Wide-field fundus photograph from neonatal ROP screening — 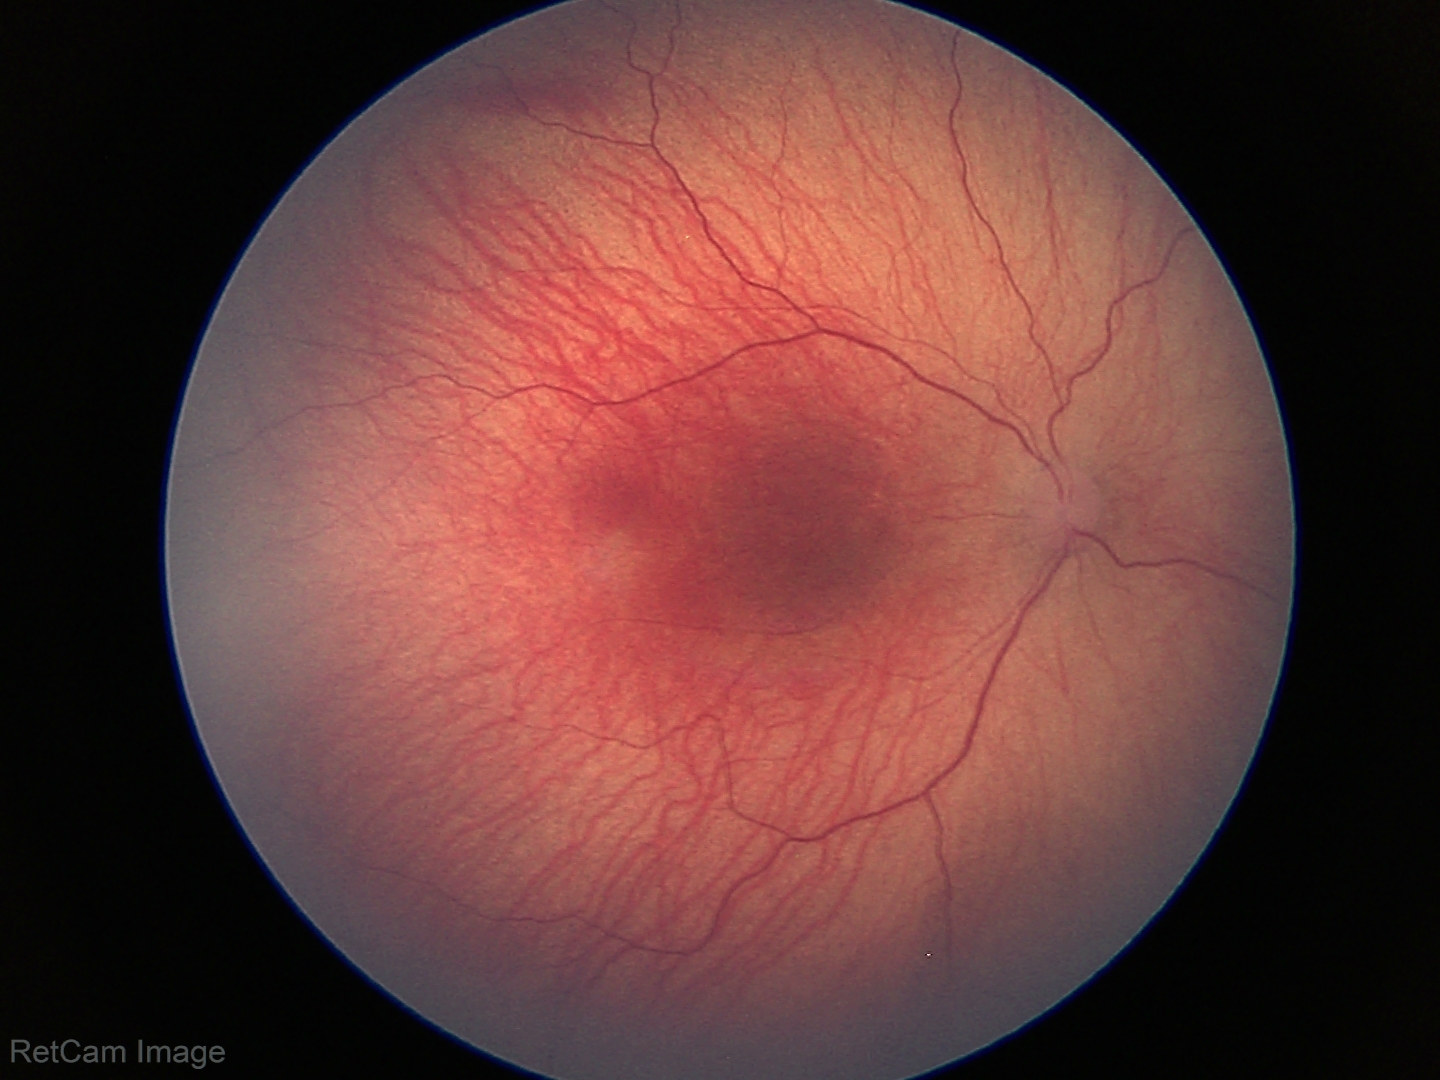

Q: What was the screening finding?
A: retinopathy of prematurity stage 1